Image size 848x848
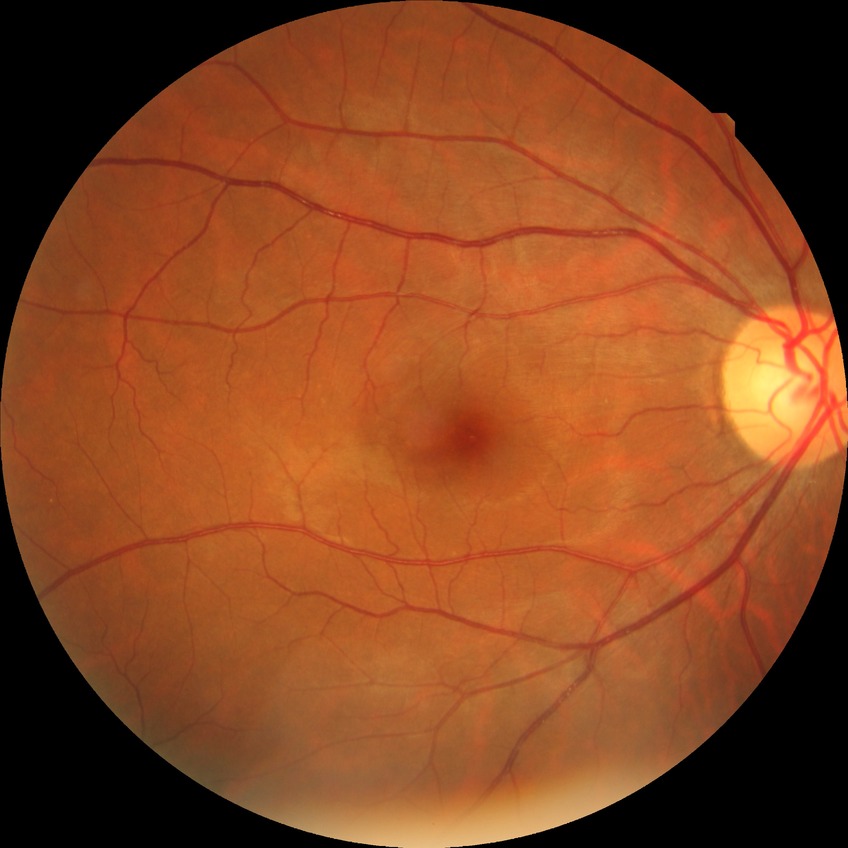
diabetic retinopathy (DR): NDR (no diabetic retinopathy).